Color fundus image.
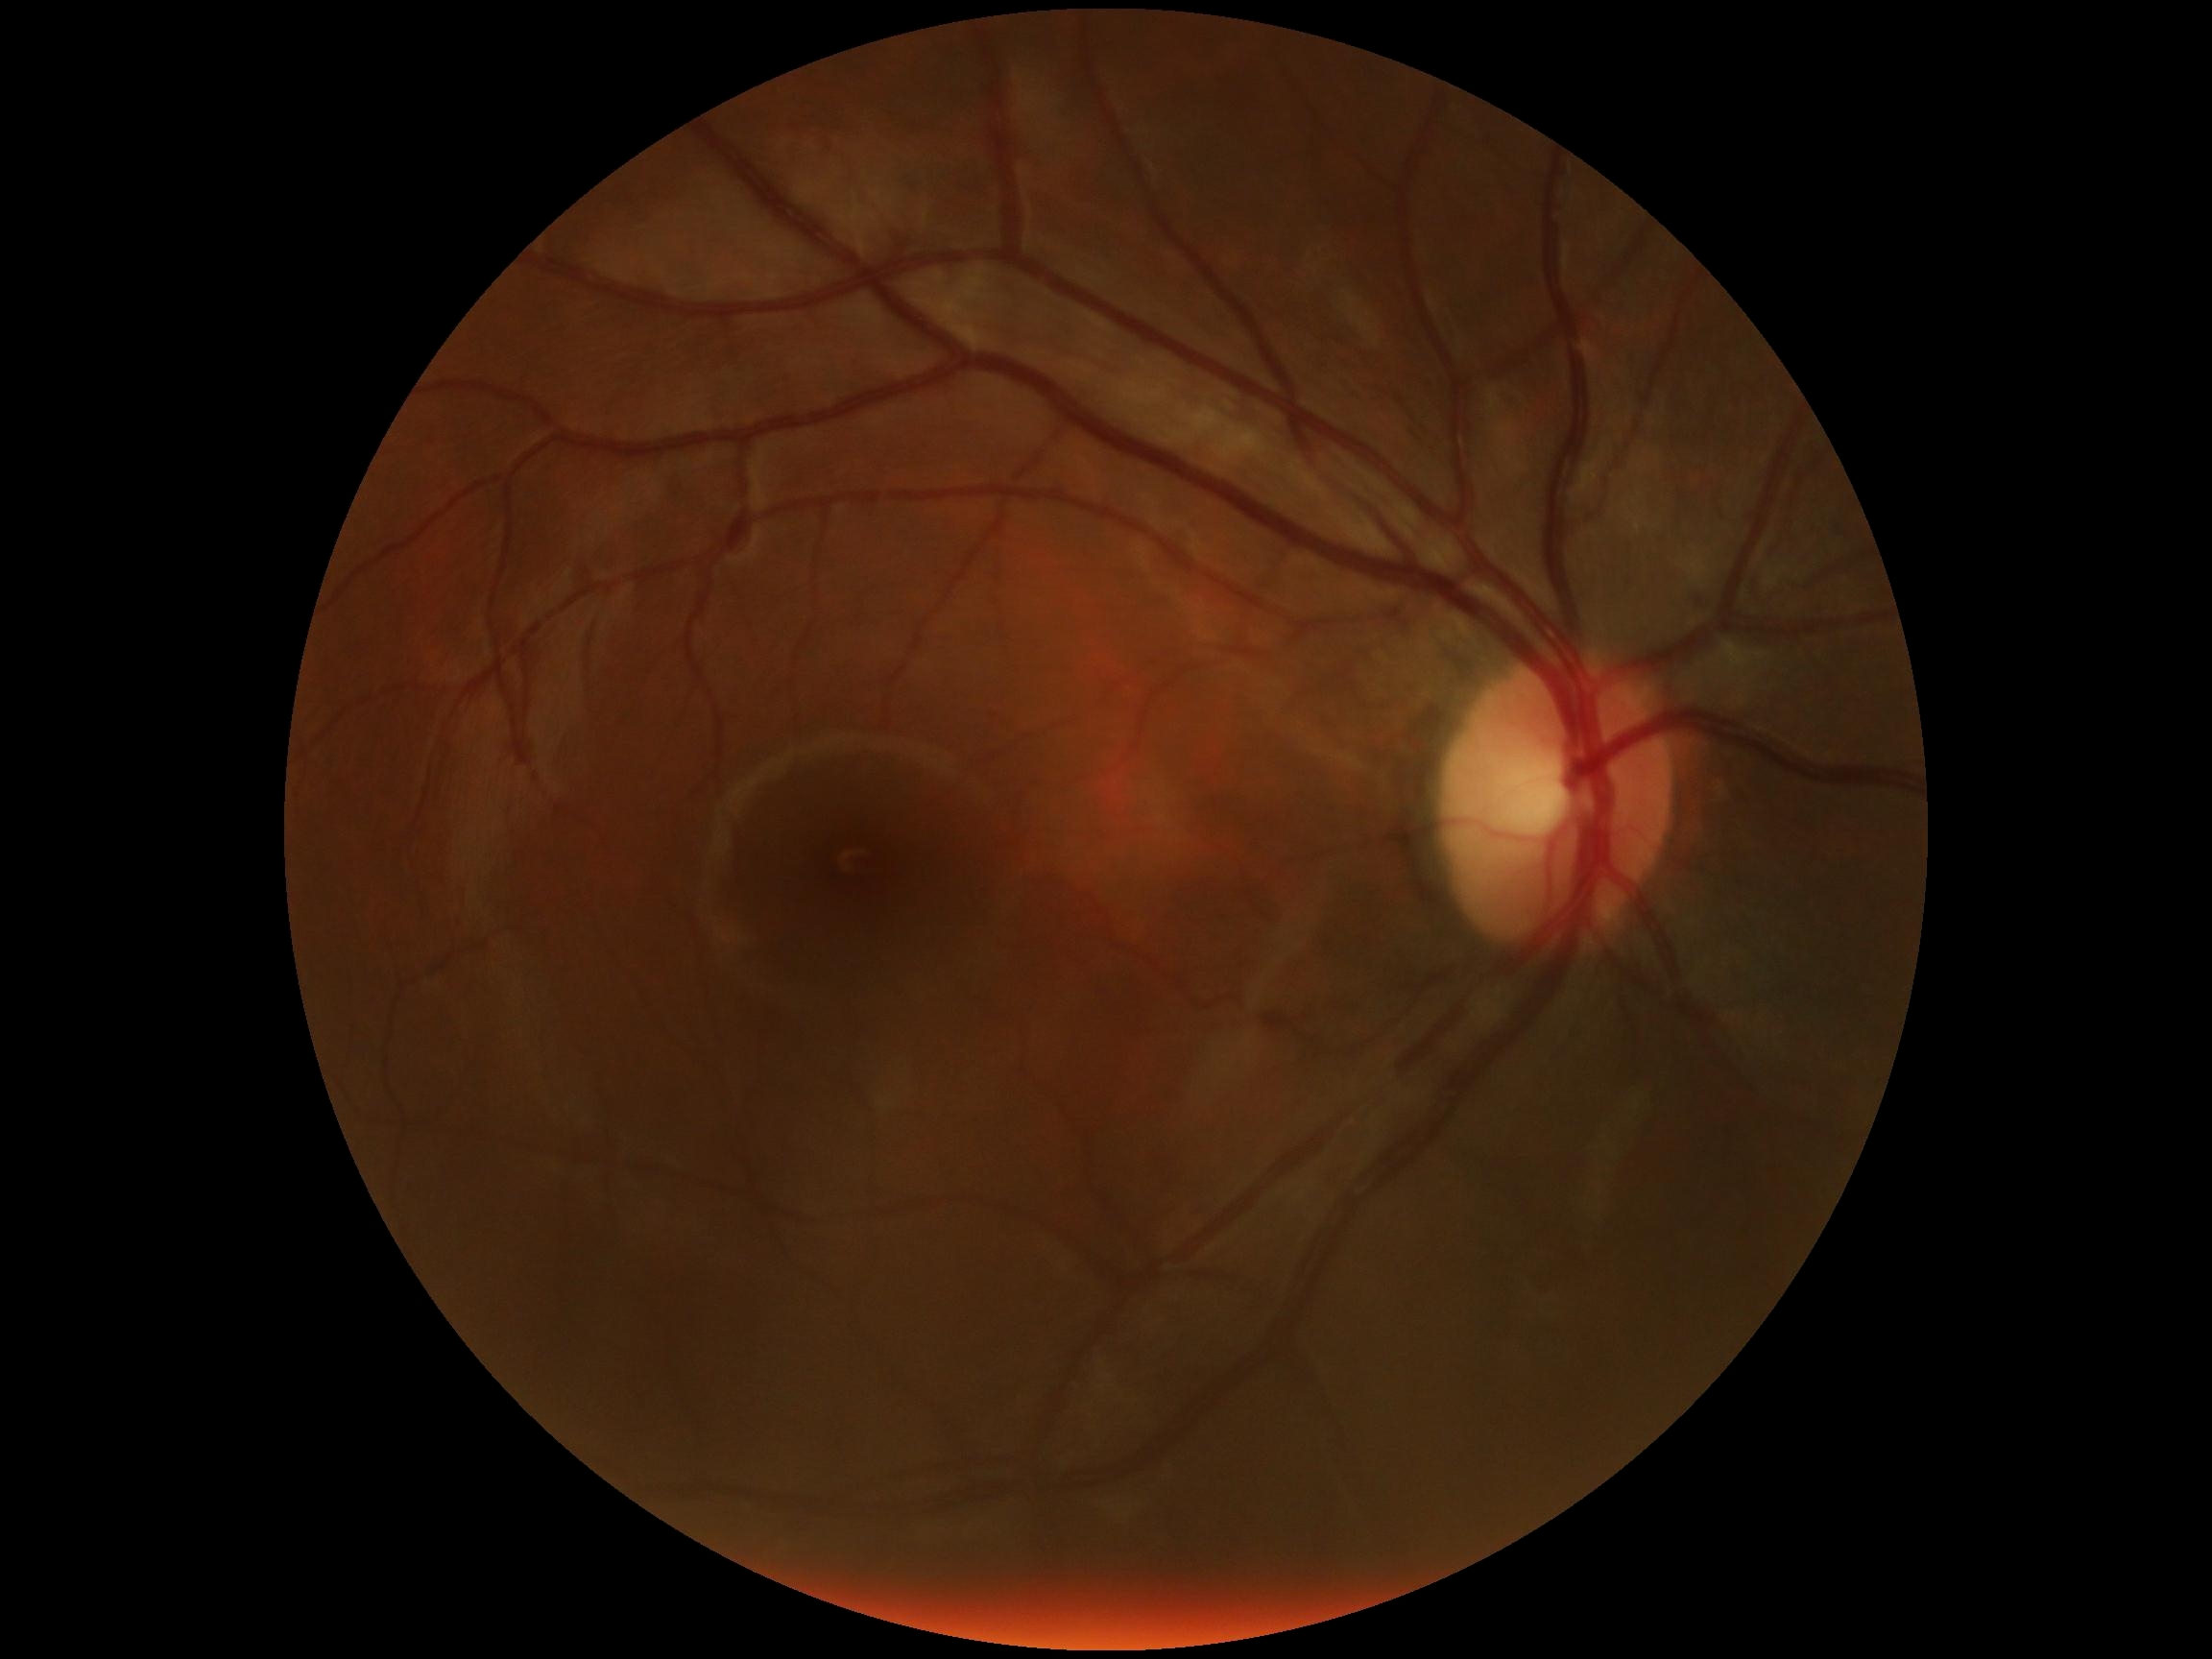 DR grade: 0.